Image size 2228x1652, captured on a Topcon TRC-50DX fundus camera, posterior pole field covering the optic disc and macula, mydriatic (tropicamide and phenylephrine):
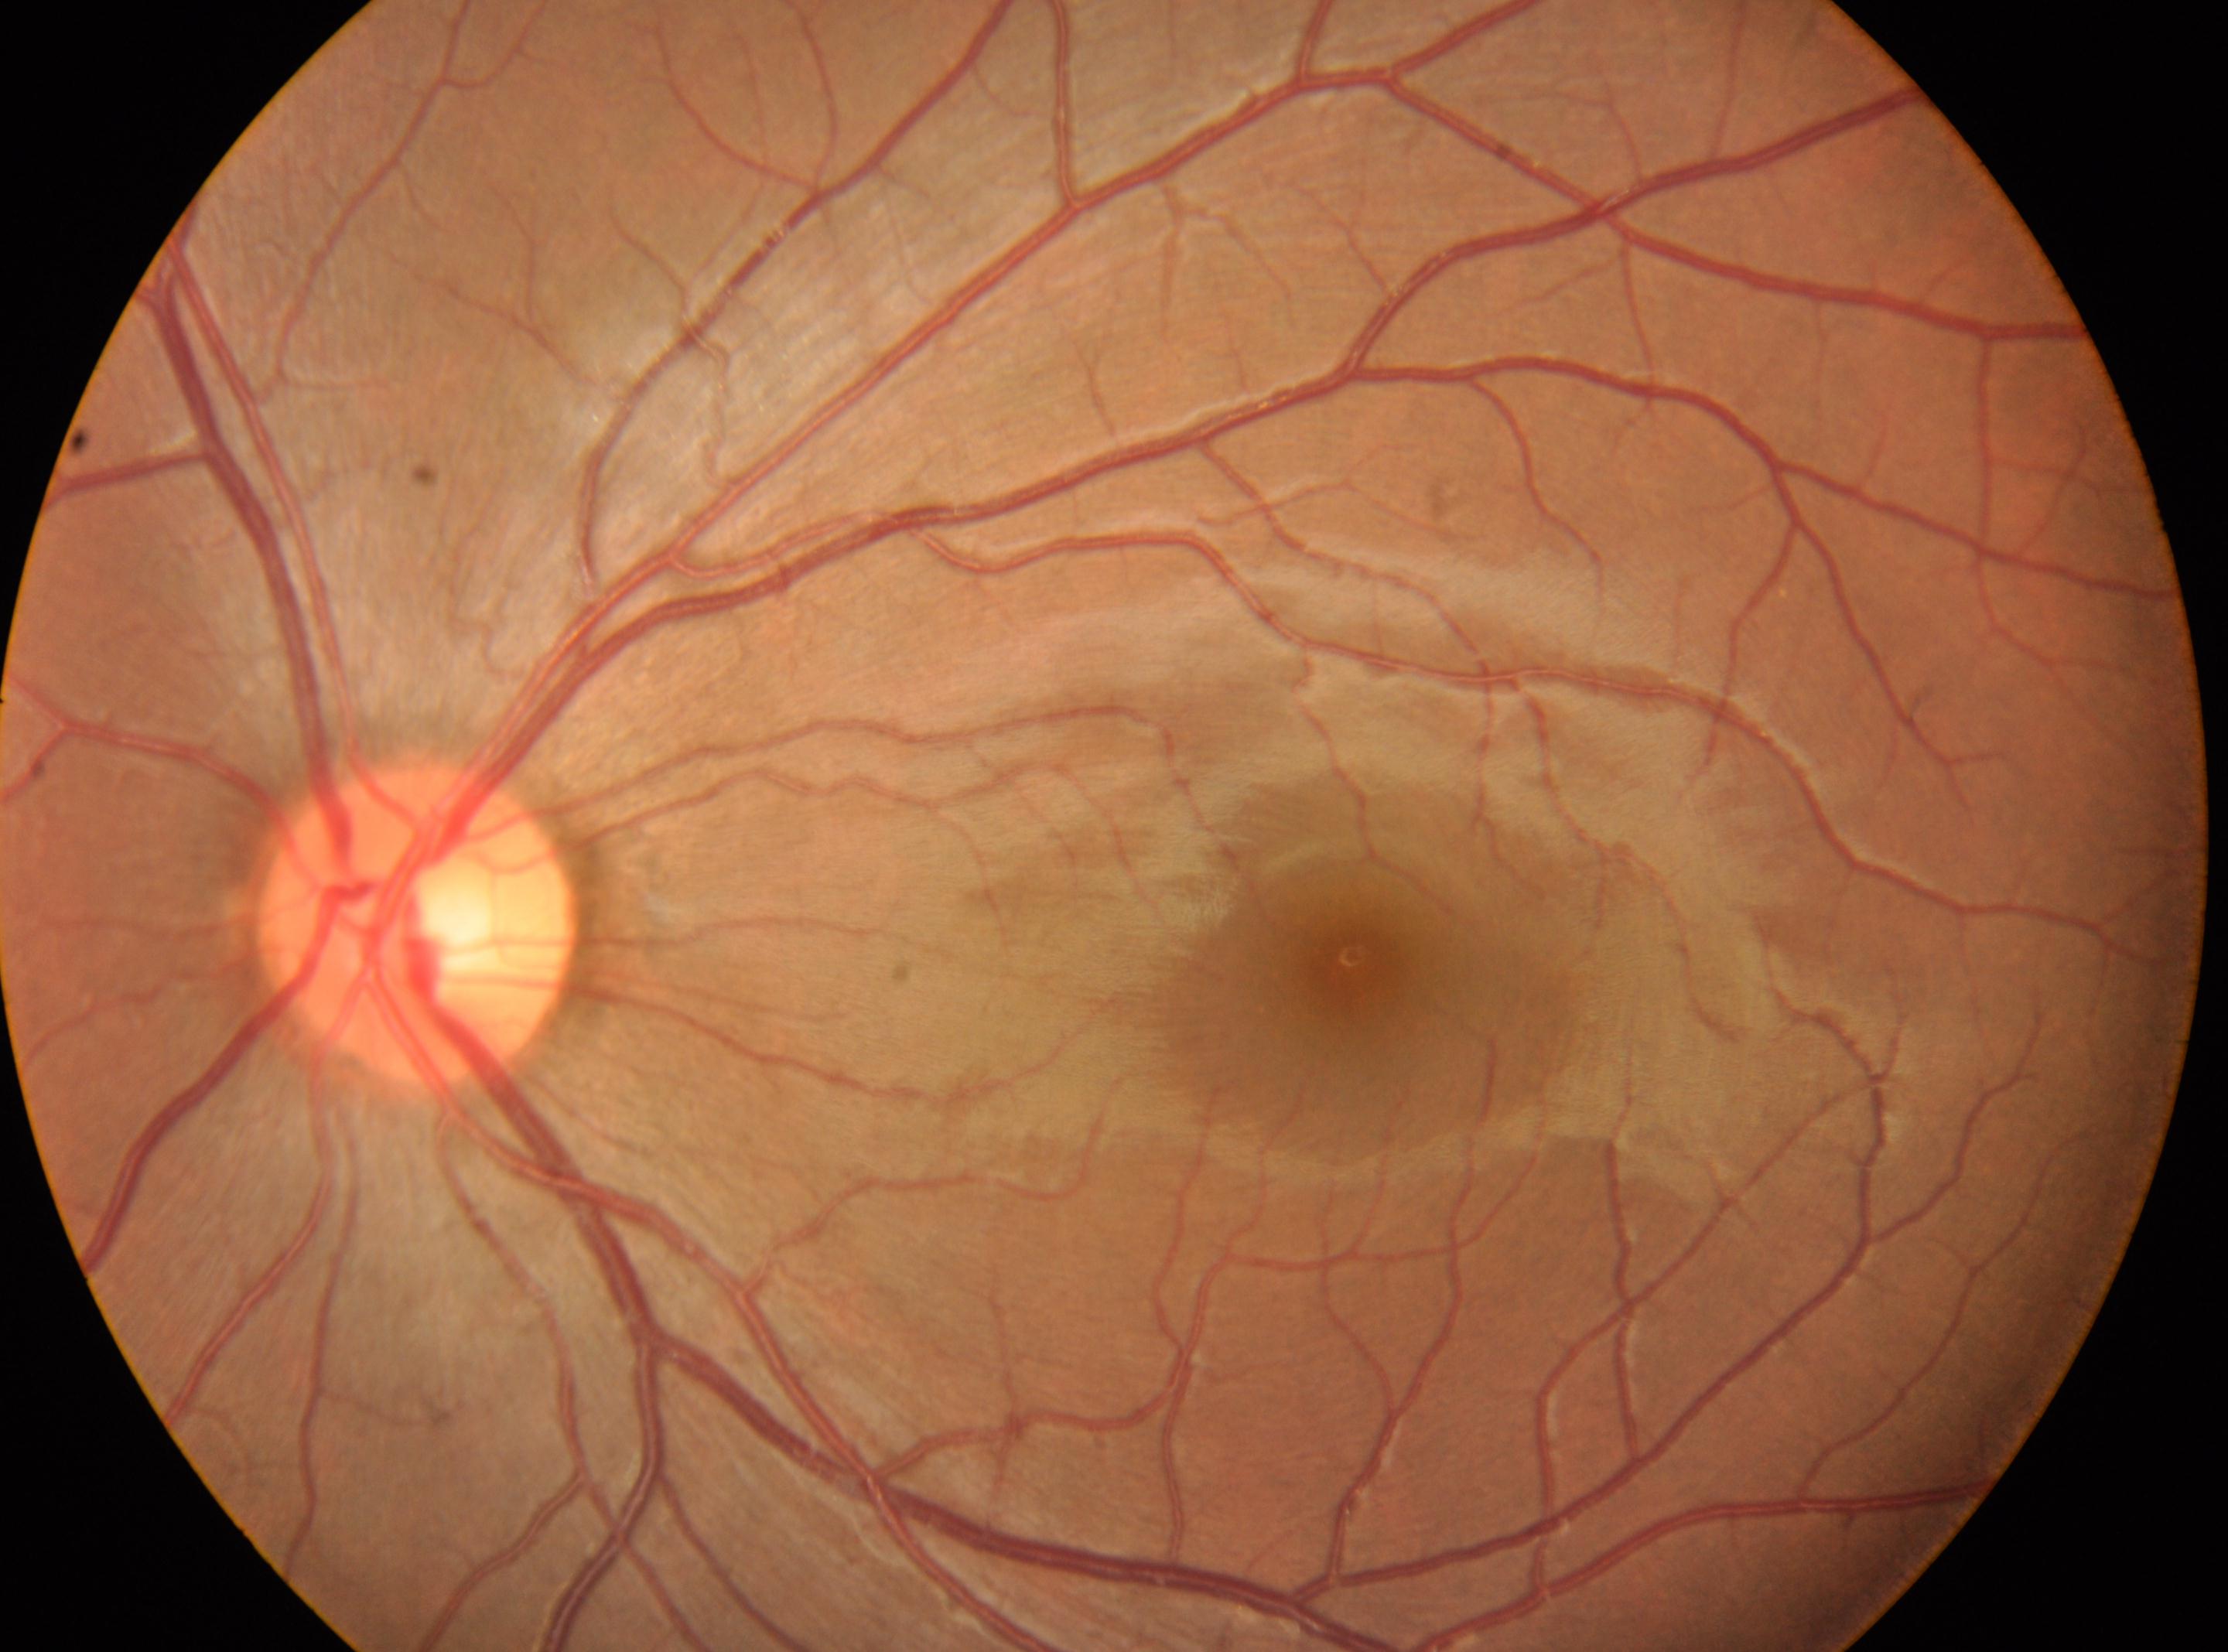

optic disc center=(x: 415, y: 922)
fovea centralis=(x: 1357, y: 970)
No DR findings
left
DR=grade 0 (no apparent retinopathy)